Image size 848x848; without pupil dilation; 45-degree field of view; diabetic retinopathy graded by the modified Davis classification; retinal fundus photograph — 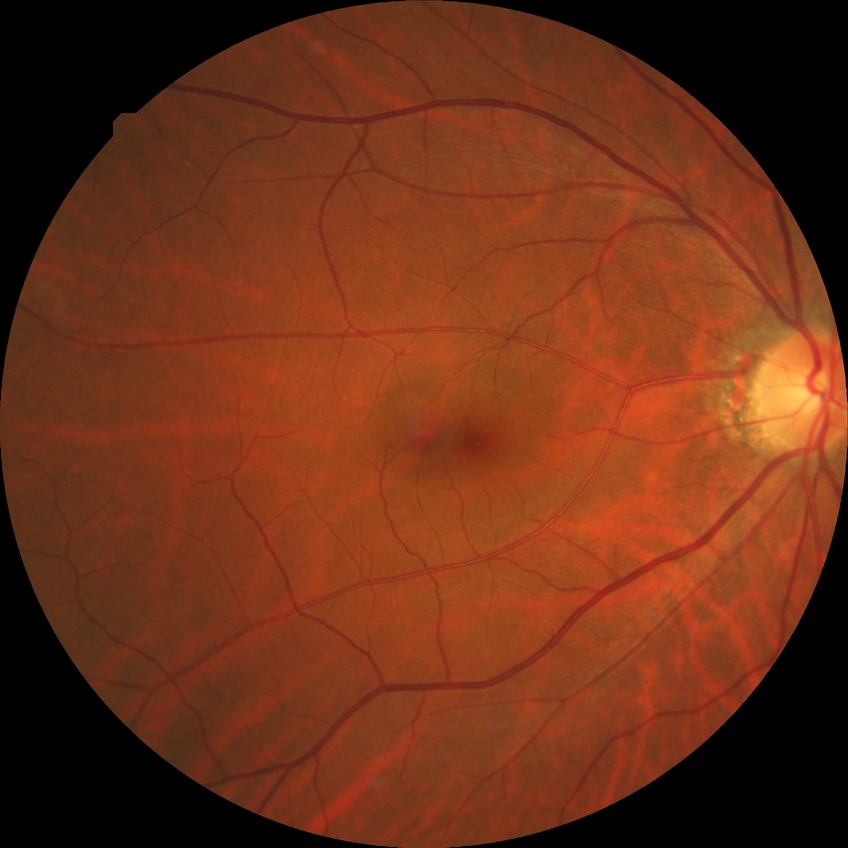

Retinopathy stage: simple diabetic retinopathy.